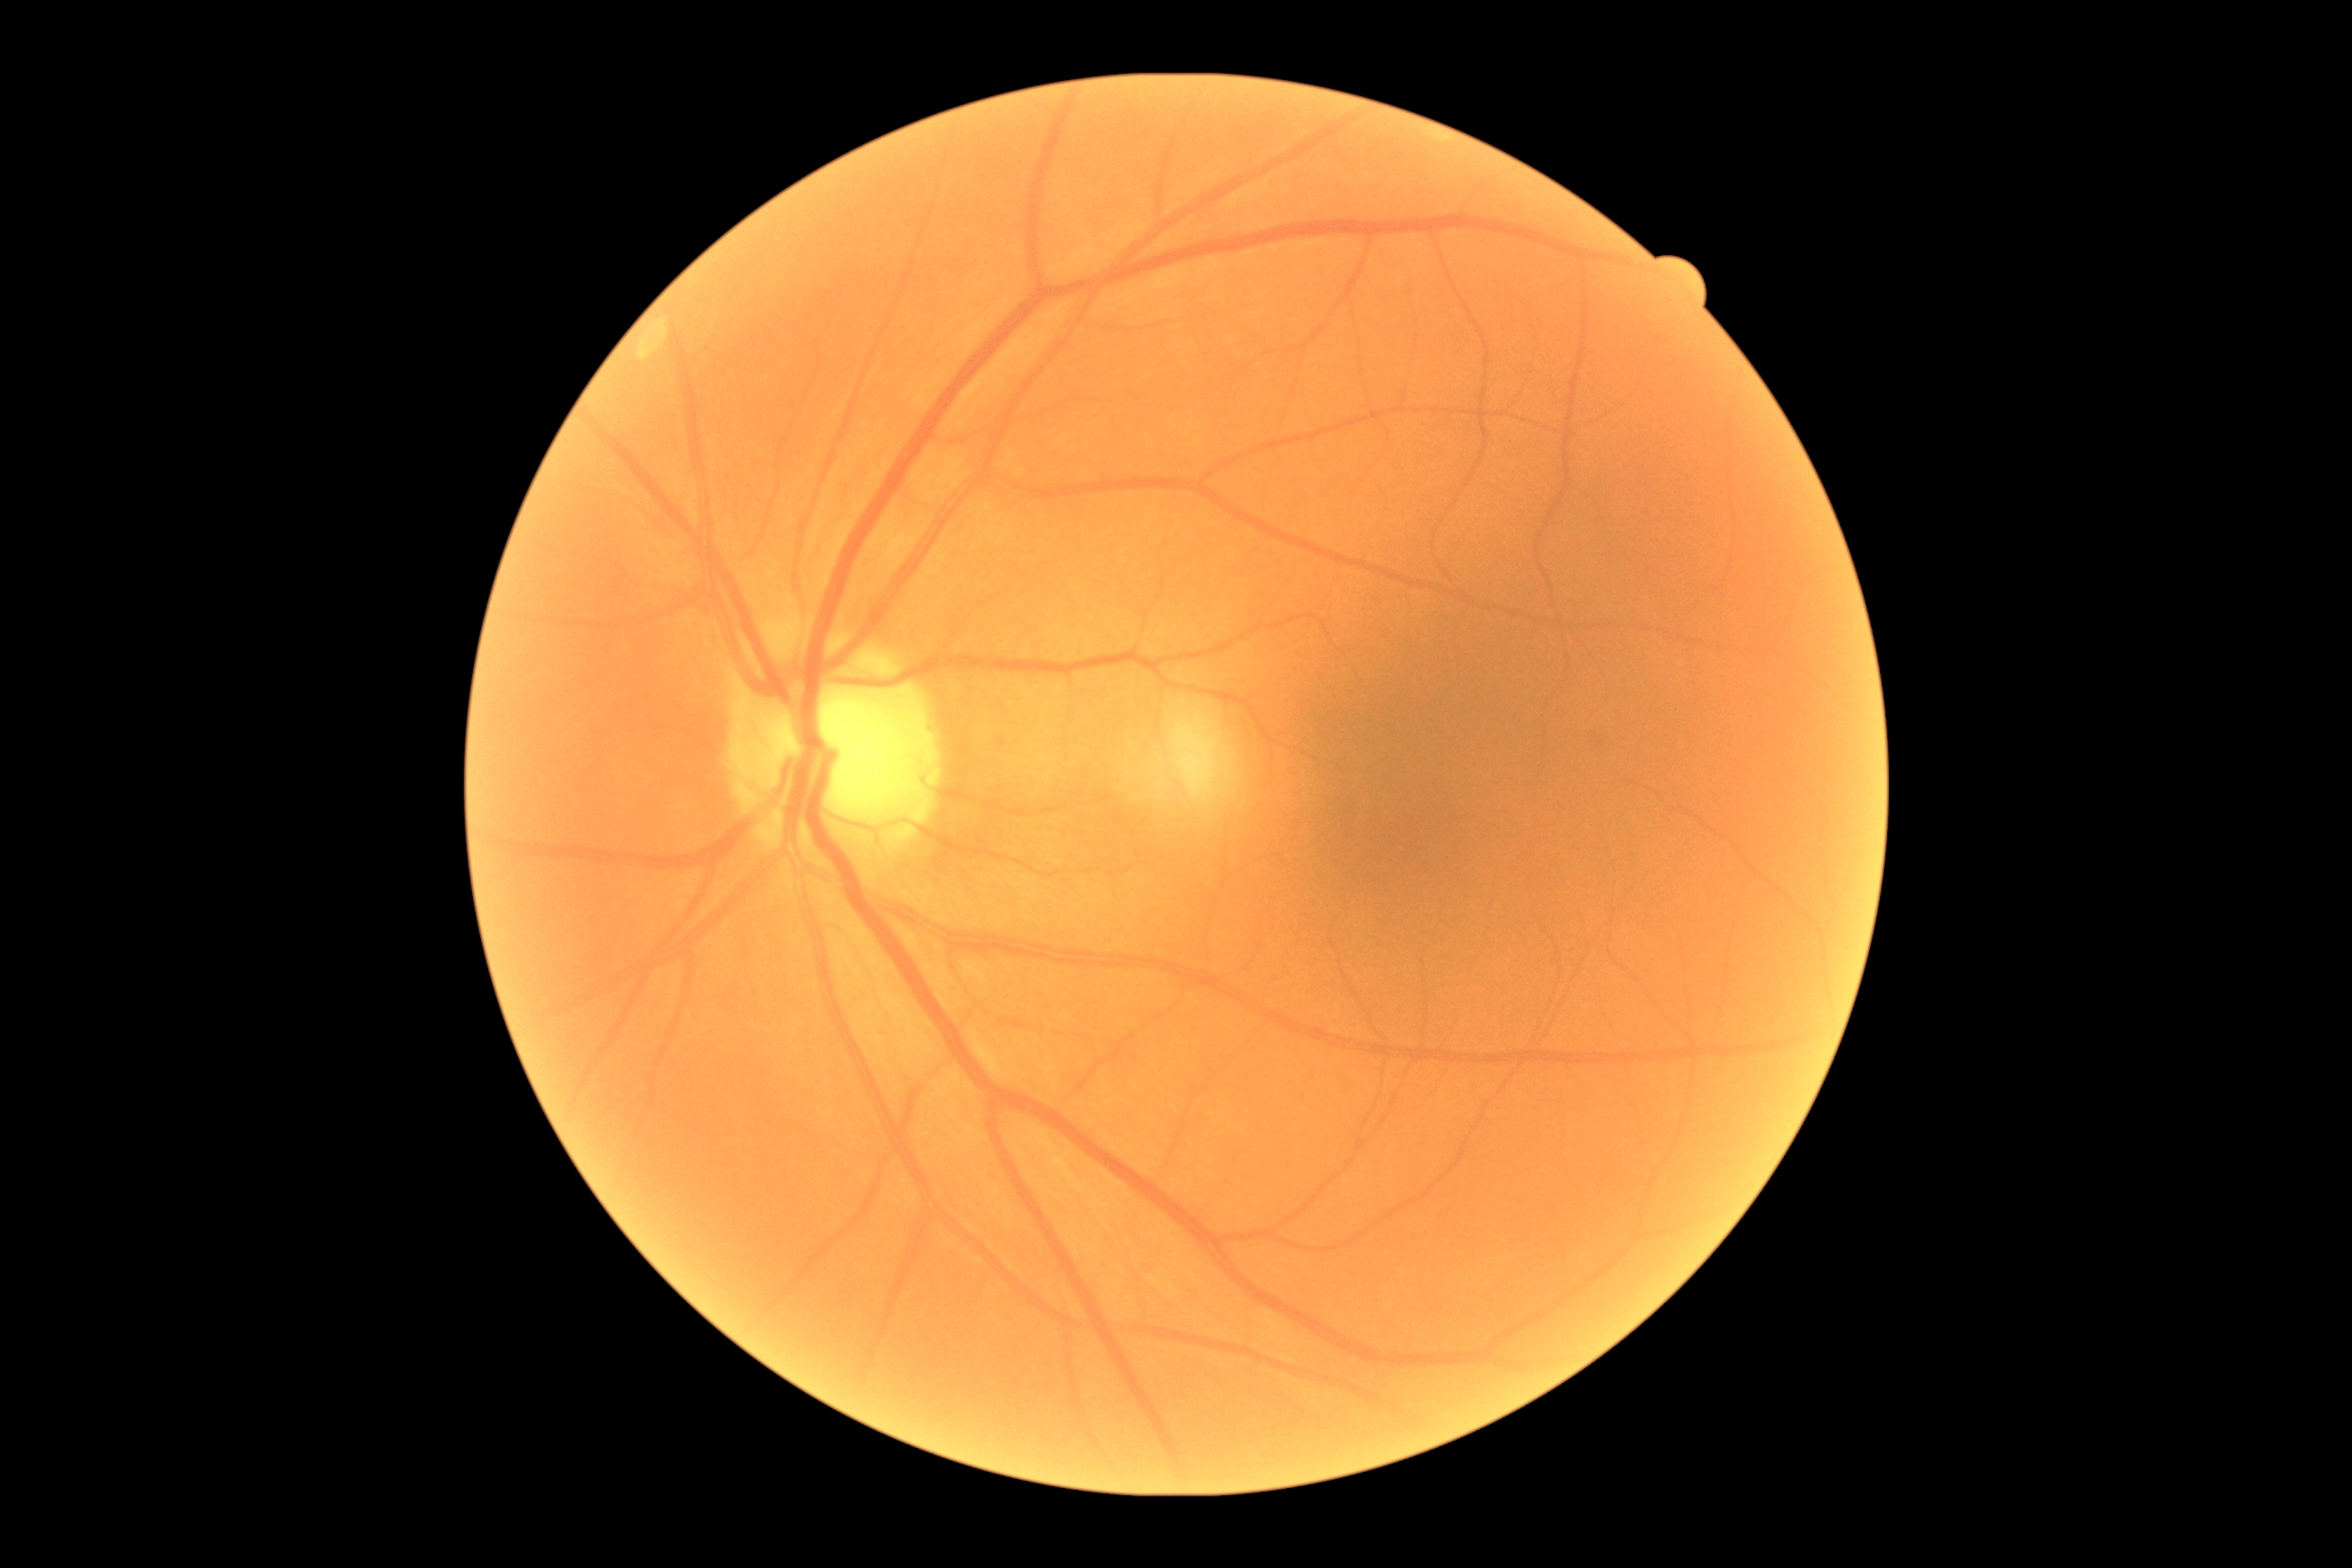 Diabetic retinopathy grade is 0.